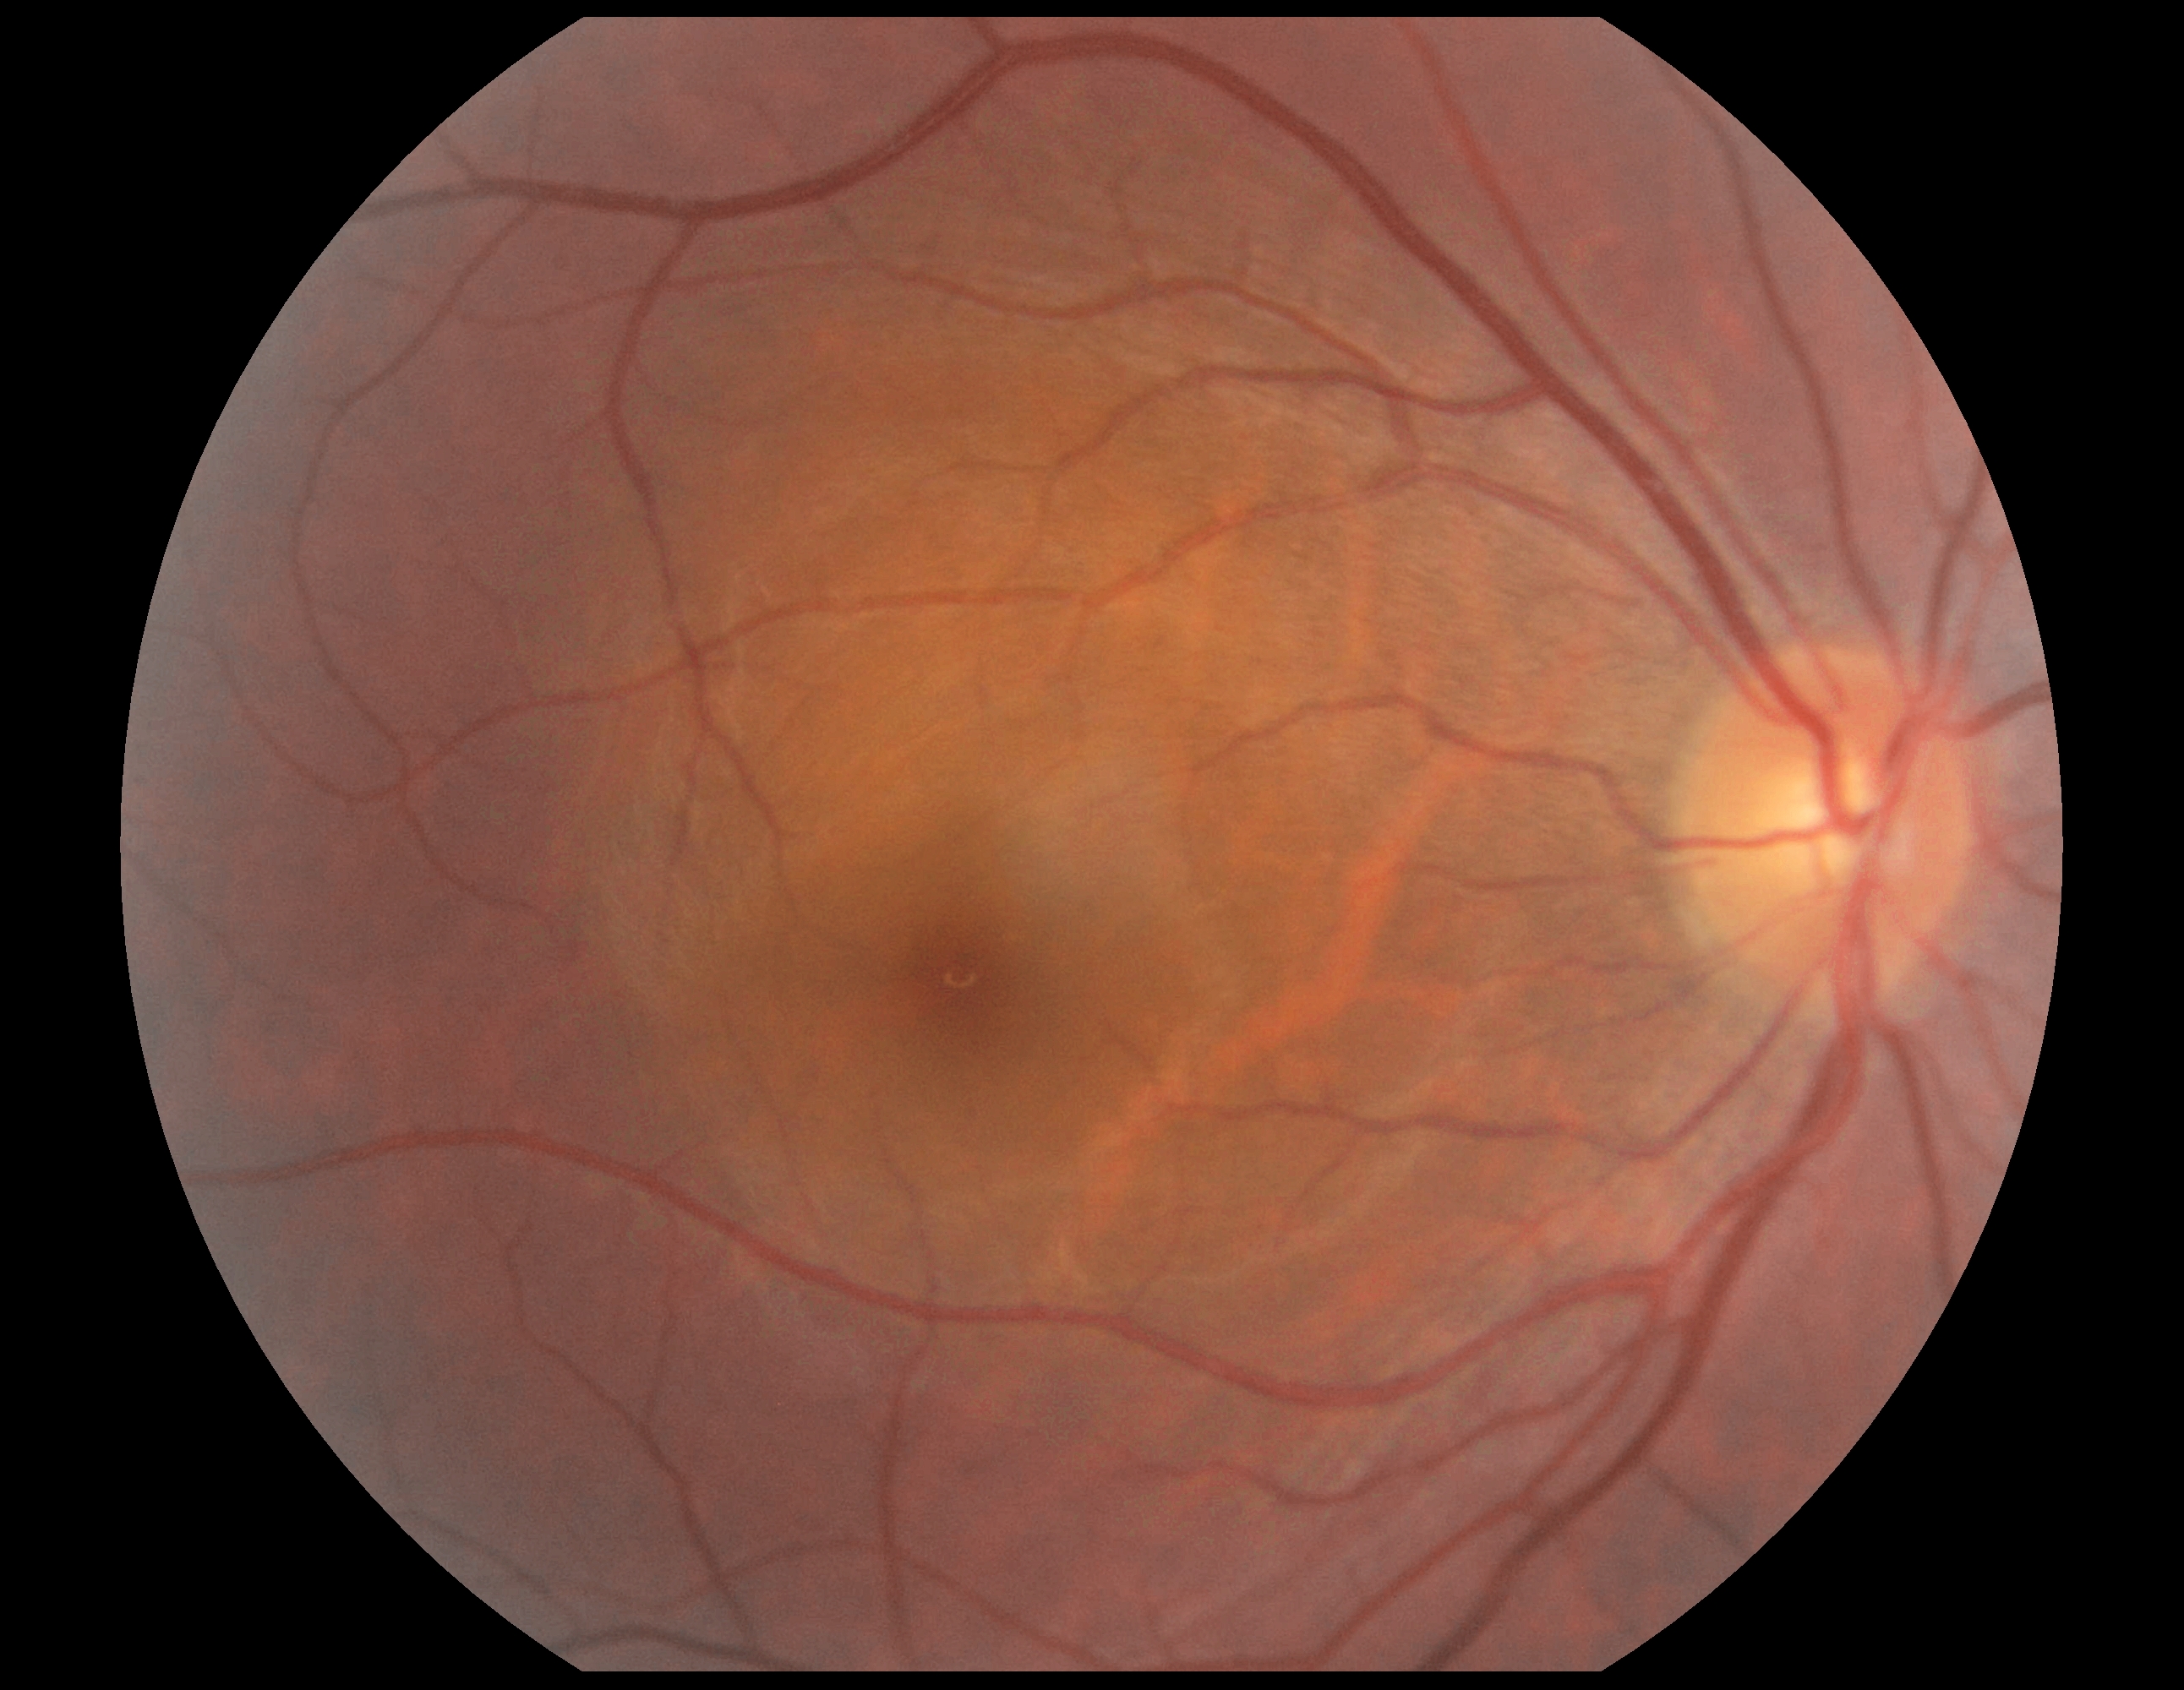
Retinopathy grade is no apparent retinopathy (0).